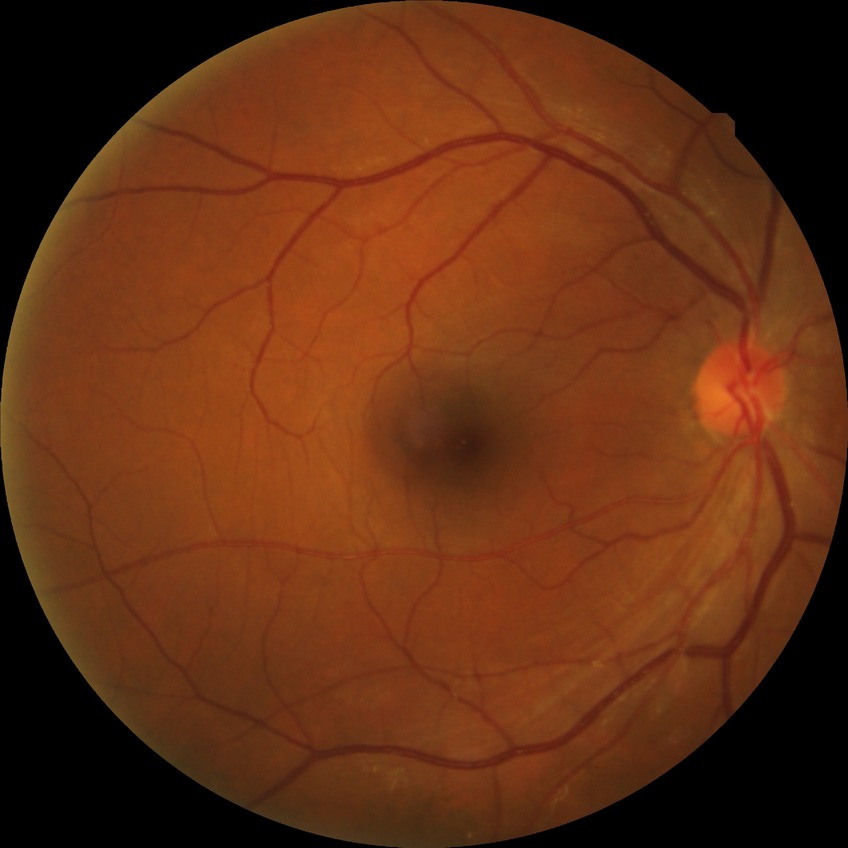
diabetic retinopathy (DR) = NDR (no diabetic retinopathy)